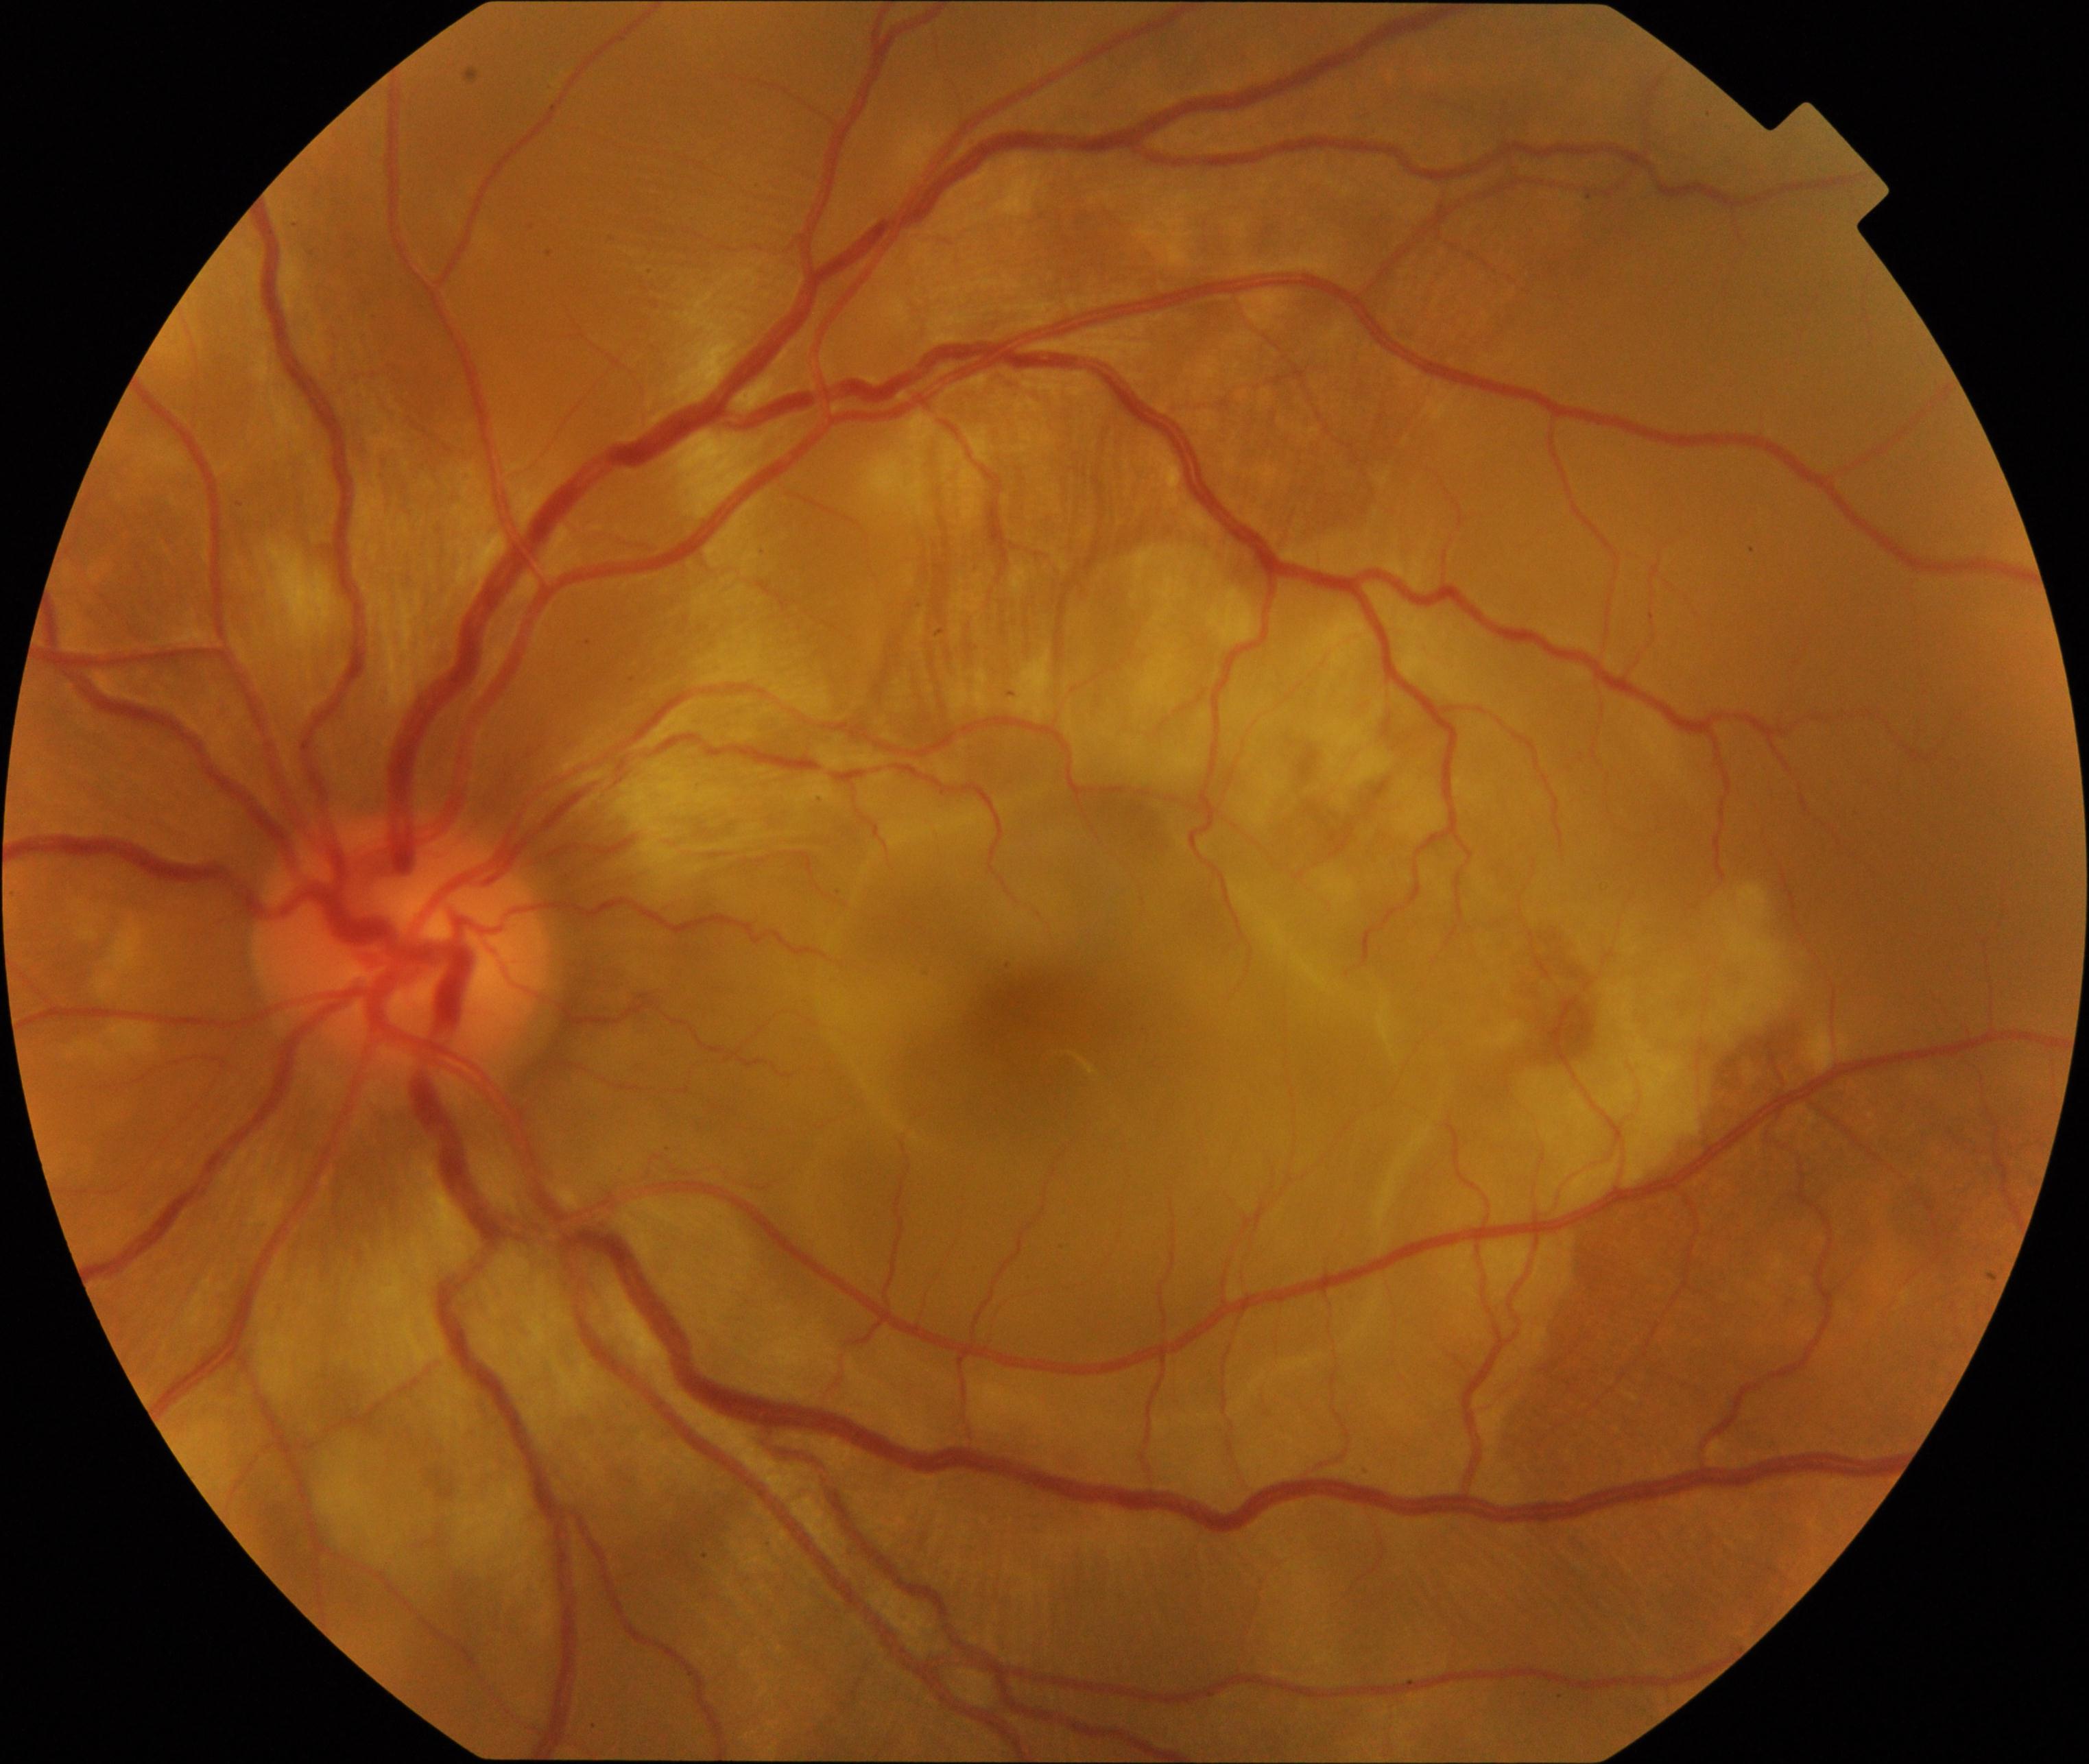

This fundus photograph shows VKH (Vogt-Koyanagi-Harada disease).